Diabetic retinopathy graded by the modified Davis classification — 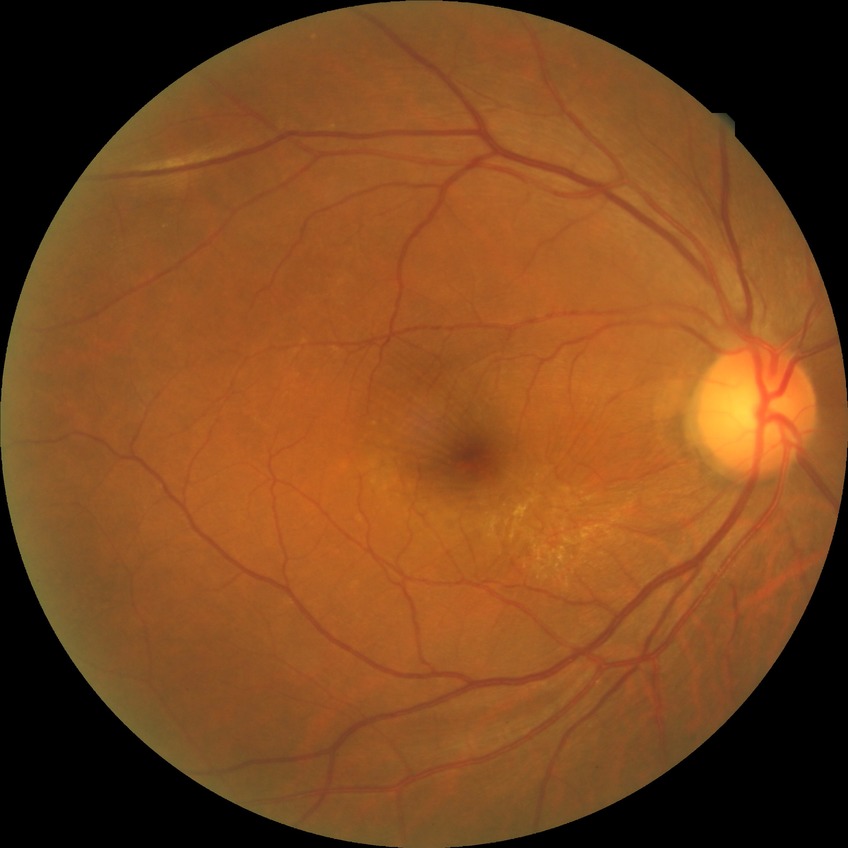
Diabetic retinopathy (DR) is no diabetic retinopathy (NDR).